Wide-field contact fundus photograph of an infant — 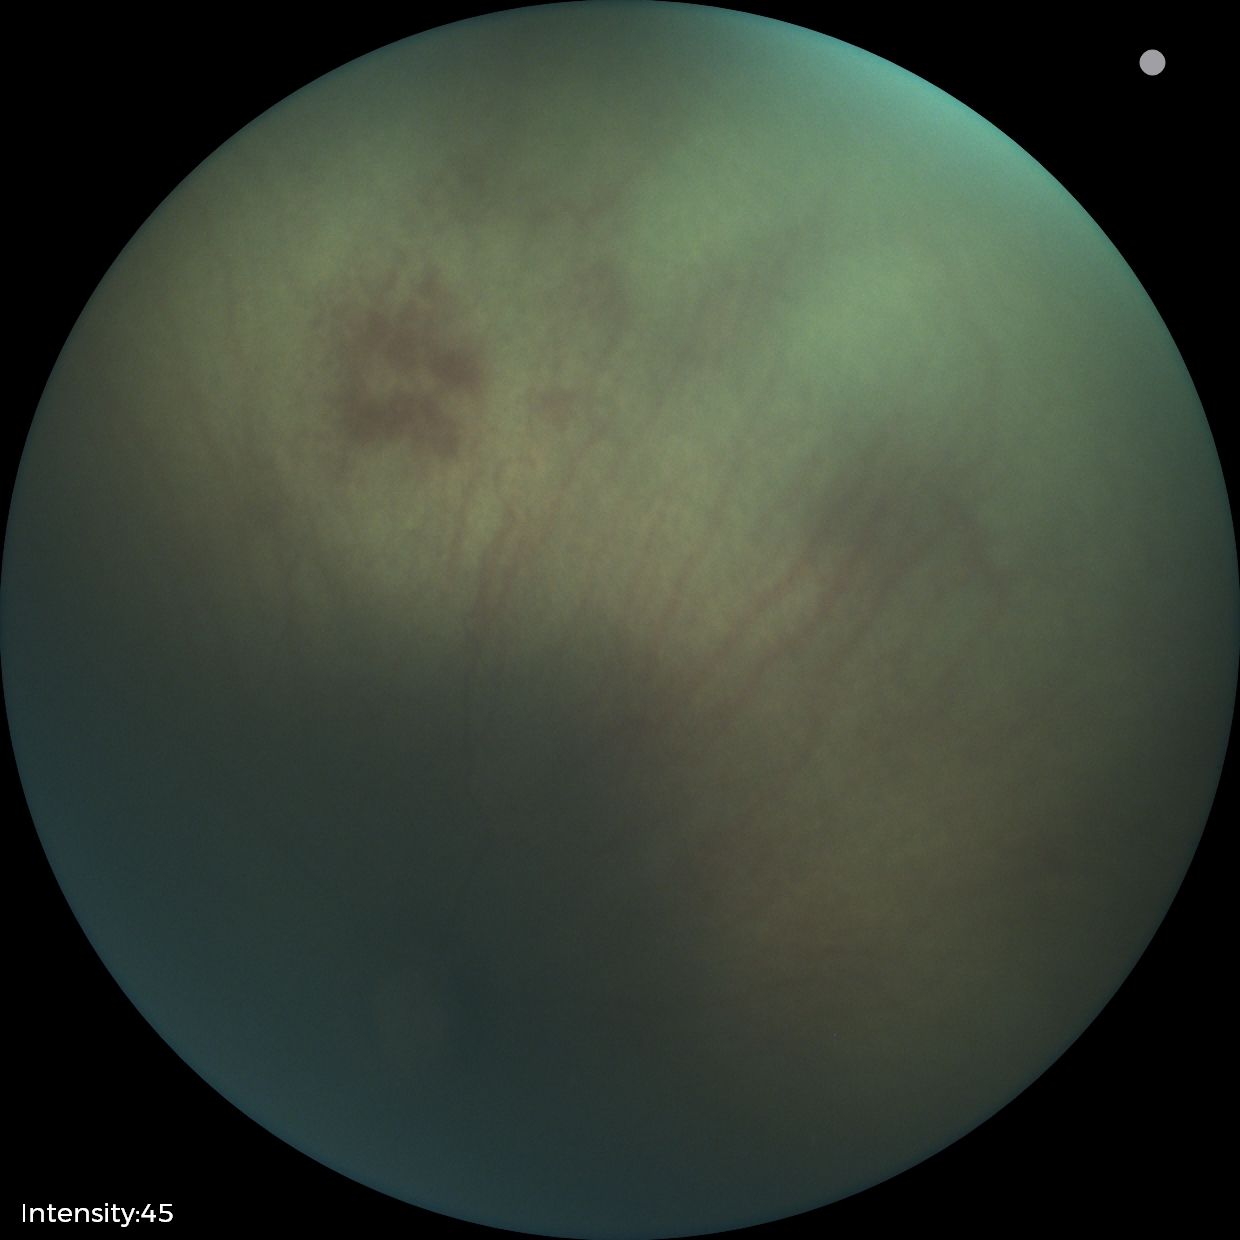
Plus disease absent.
Diagnosis from this screening exam: ROP stage 0.